Camera: NIDEK AFC-230 · FOV: 45 degrees · 848 x 848 pixels · nonmydriatic fundus photograph · CFP
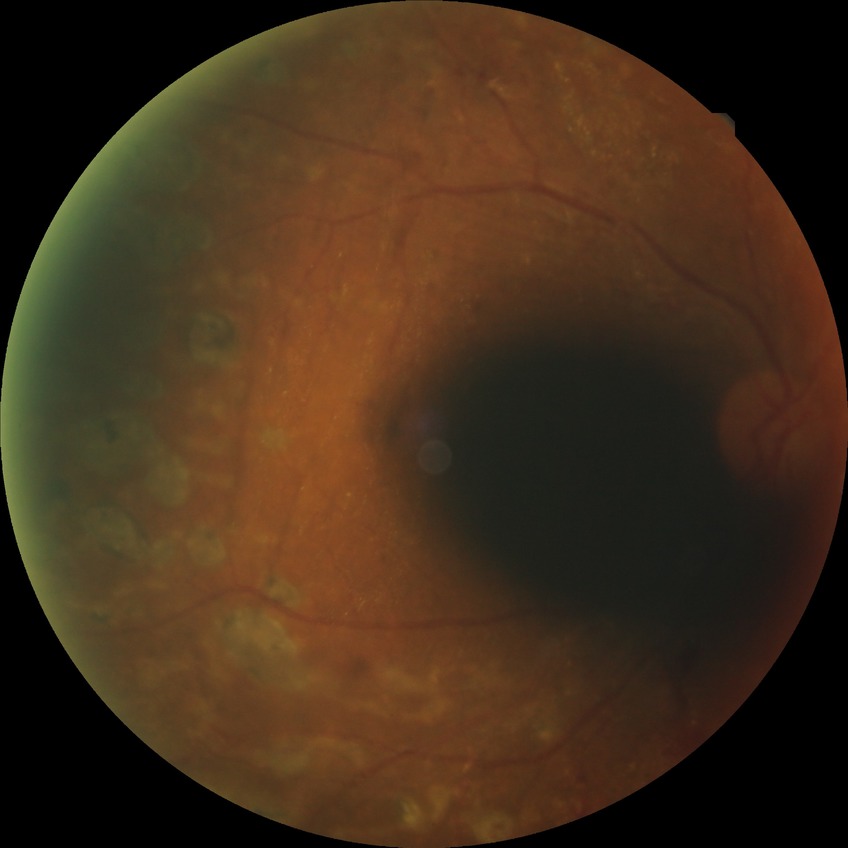 diabetic retinopathy stage=proliferative diabetic retinopathy.